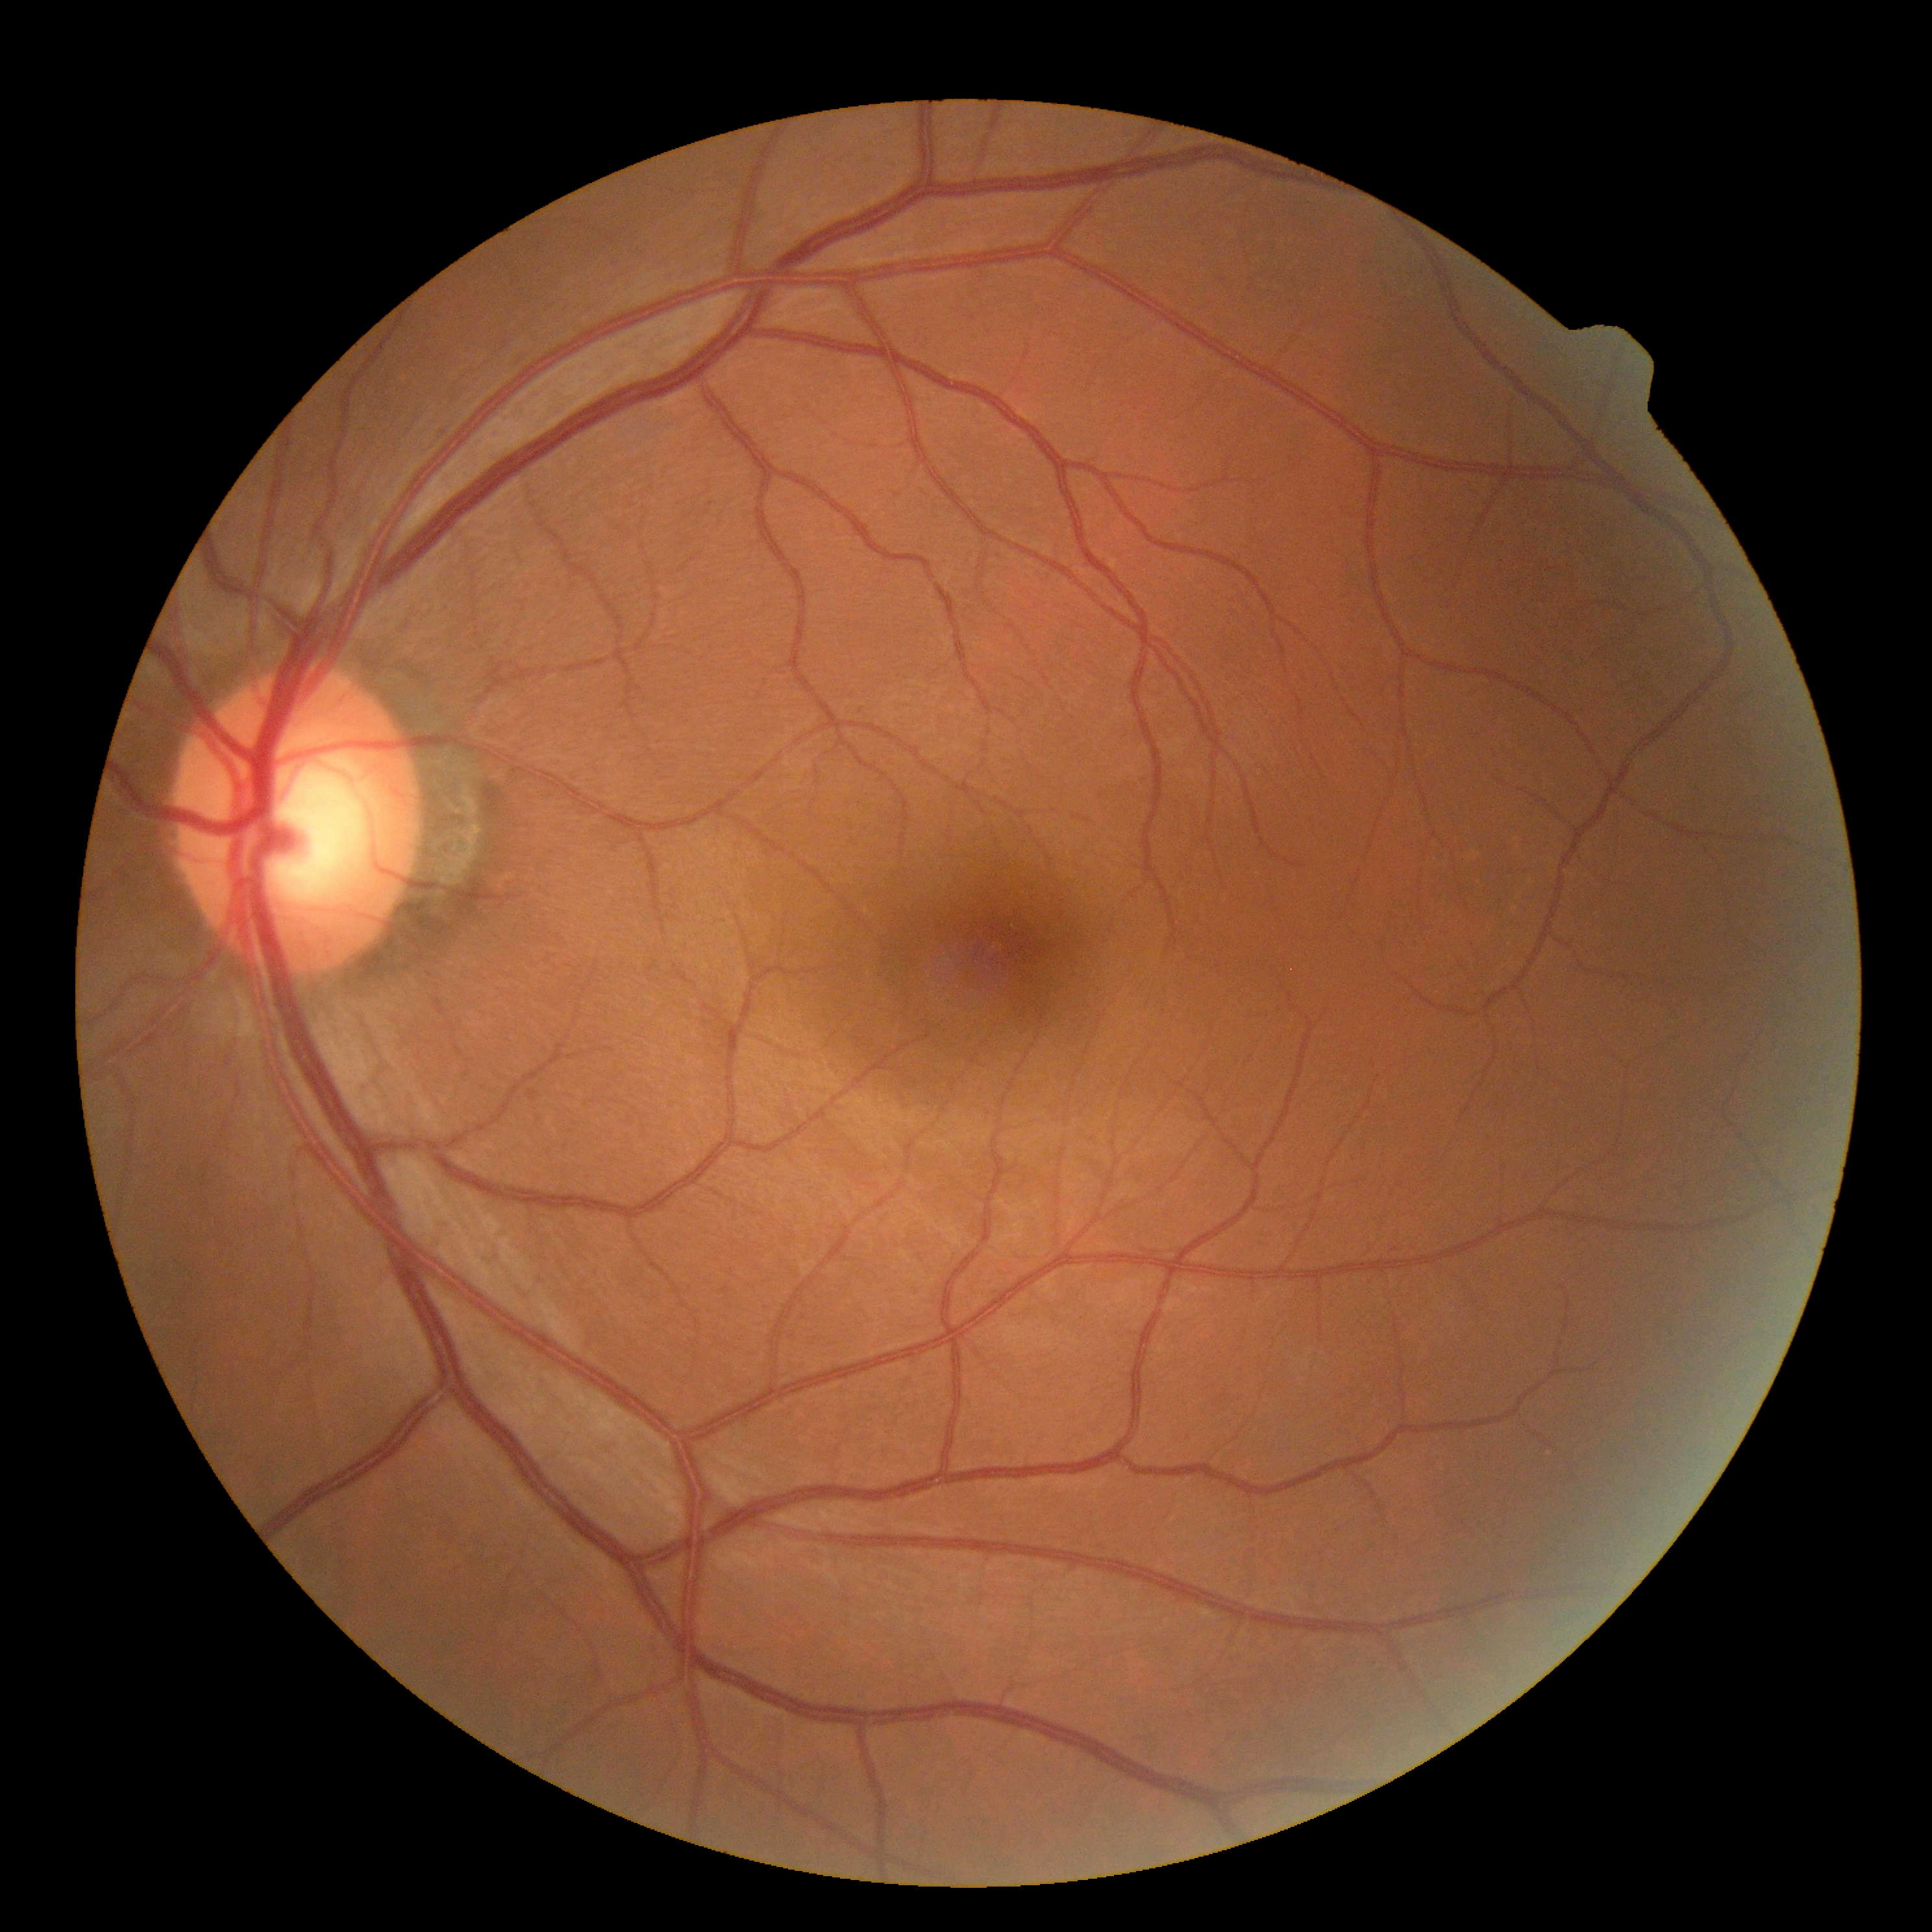 DR is grade 0 (no apparent retinopathy).